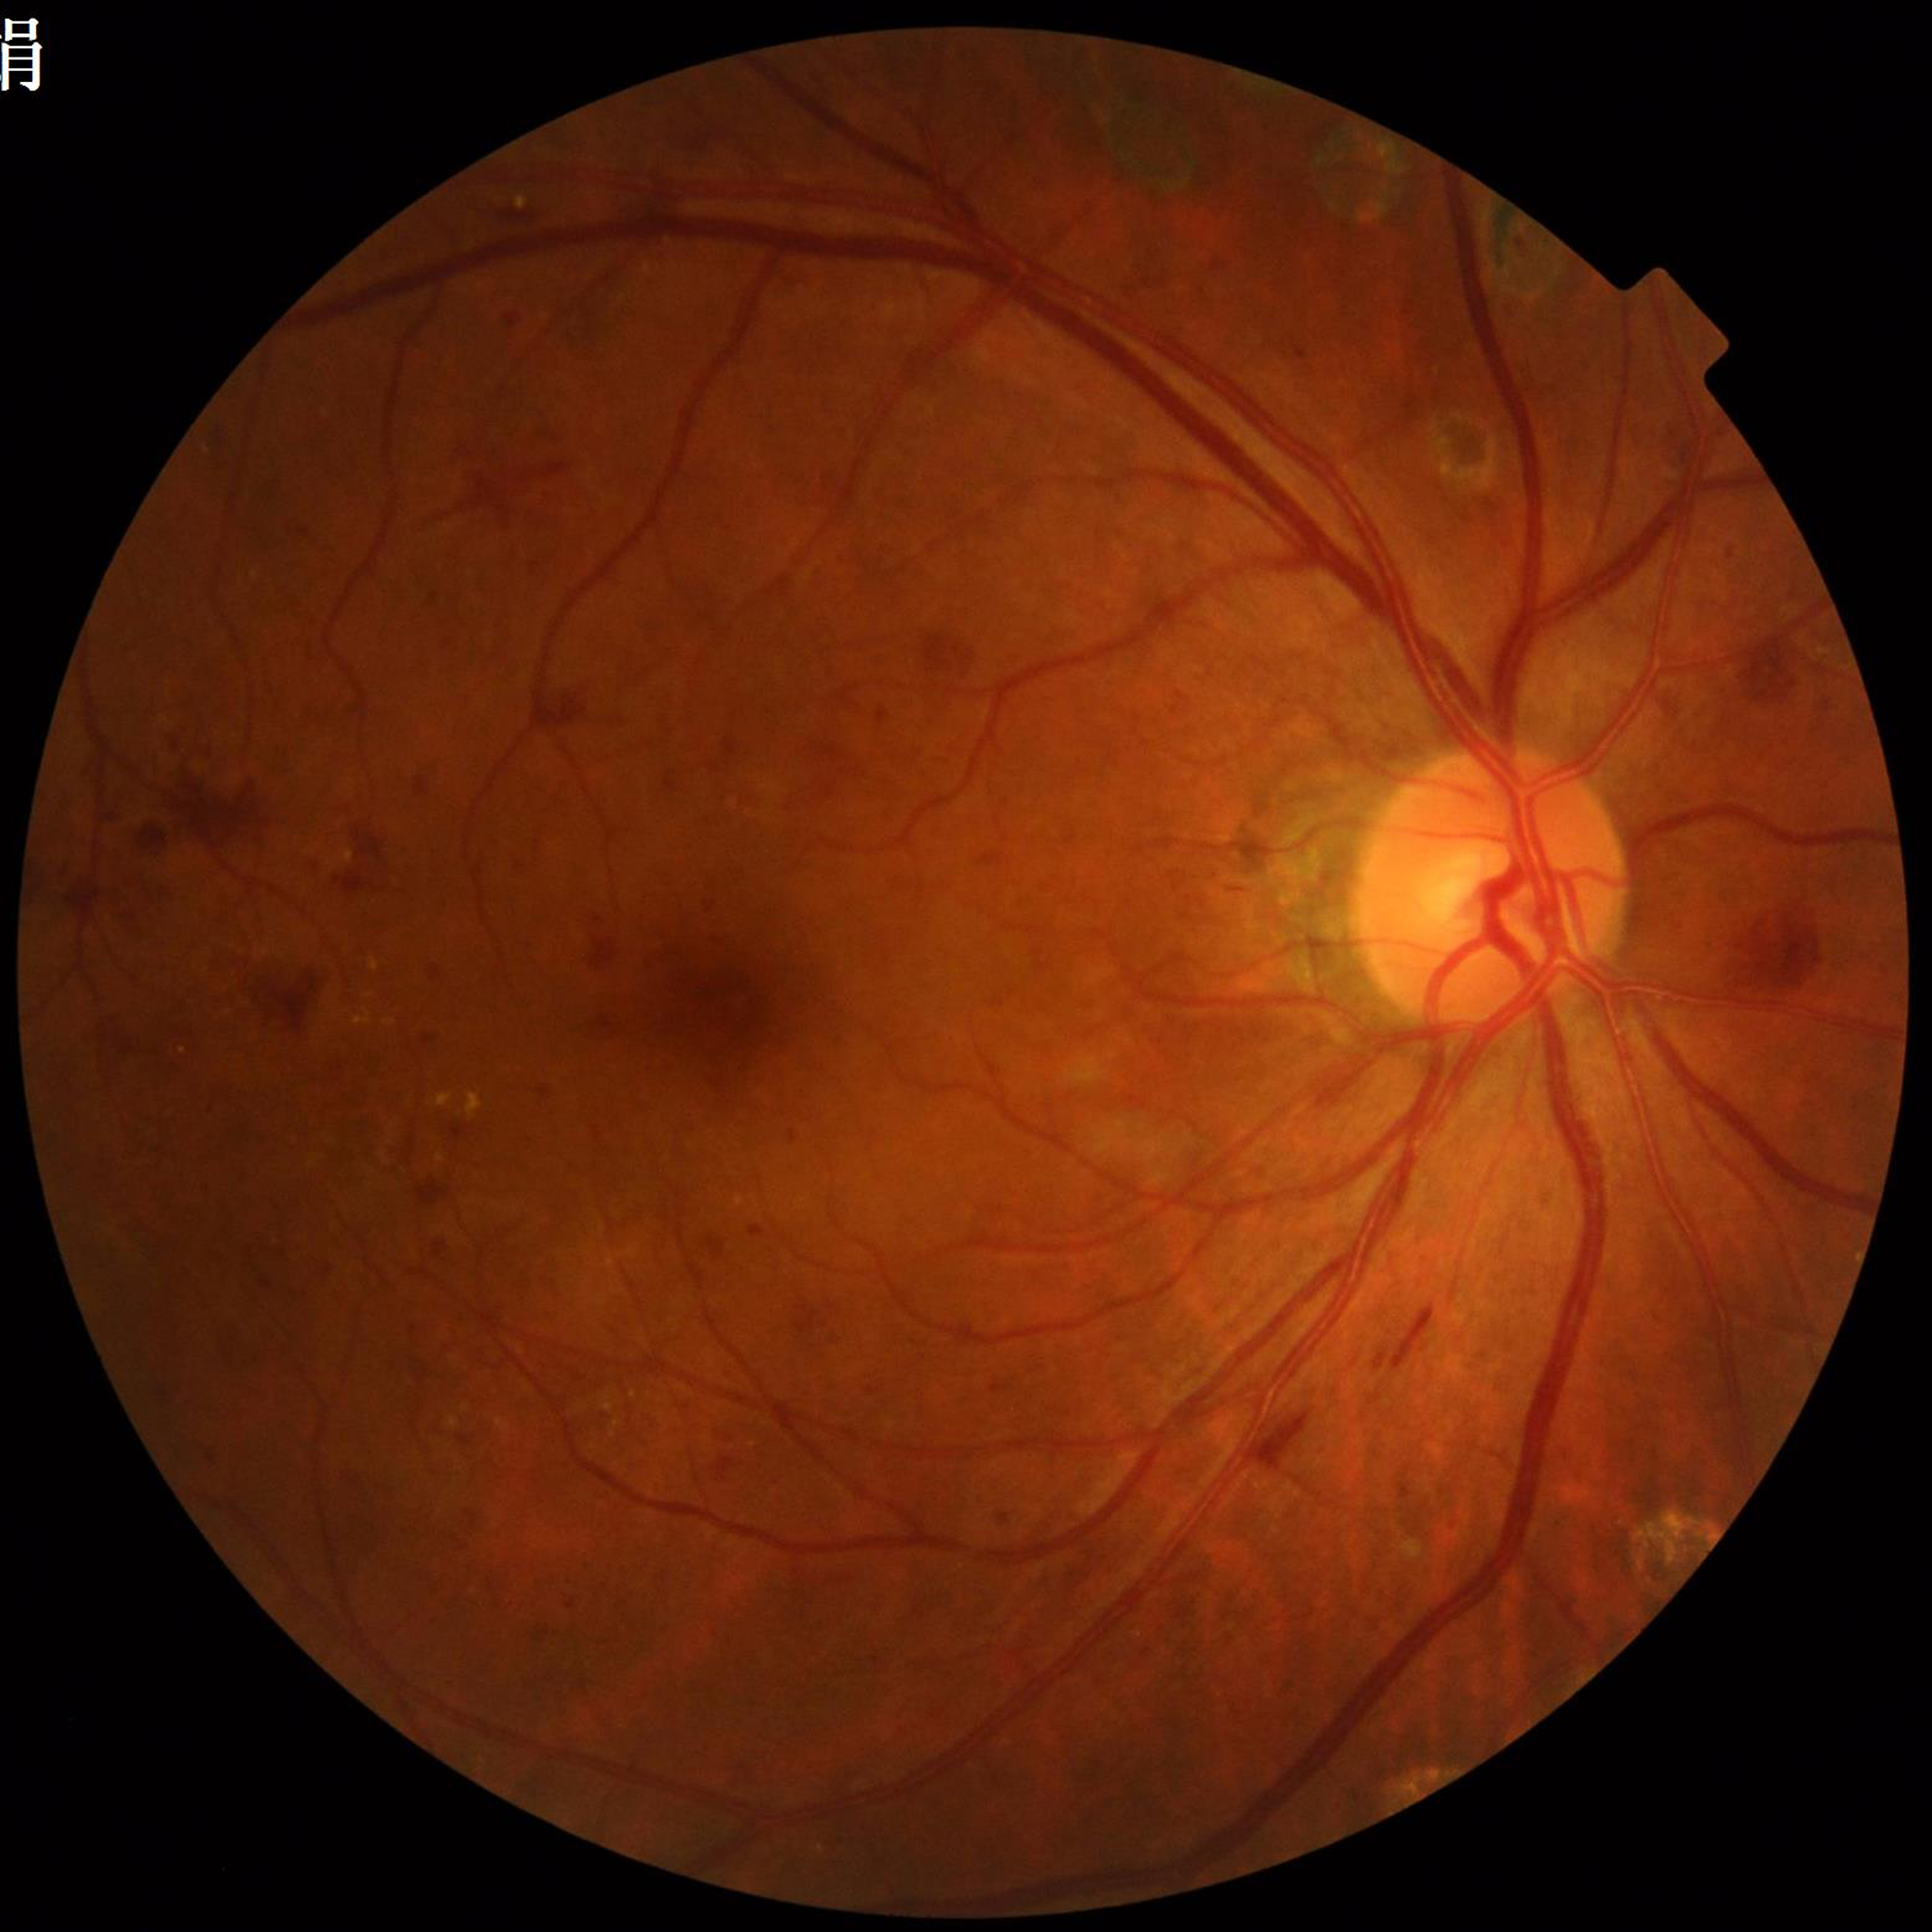

Diagnosed with diabetic retinopathy.